Camera: NIDEK AFC-230; image size 848x848
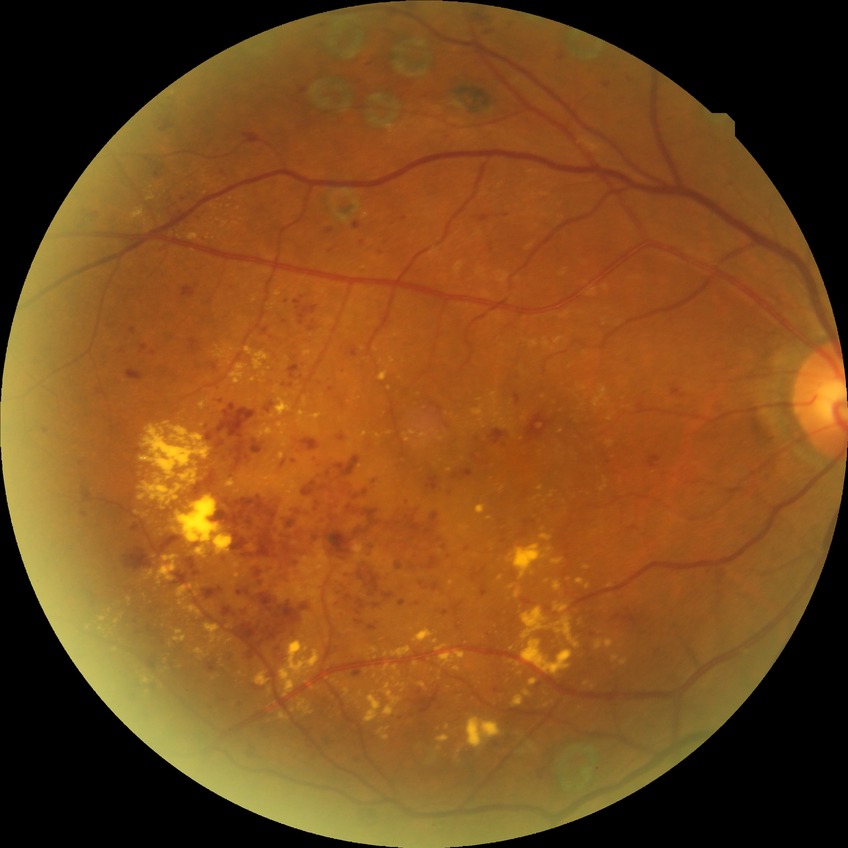

Disease class: non-proliferative diabetic retinopathy.
Diabetic retinopathy (DR) is pre-proliferative diabetic retinopathy (PPDR).